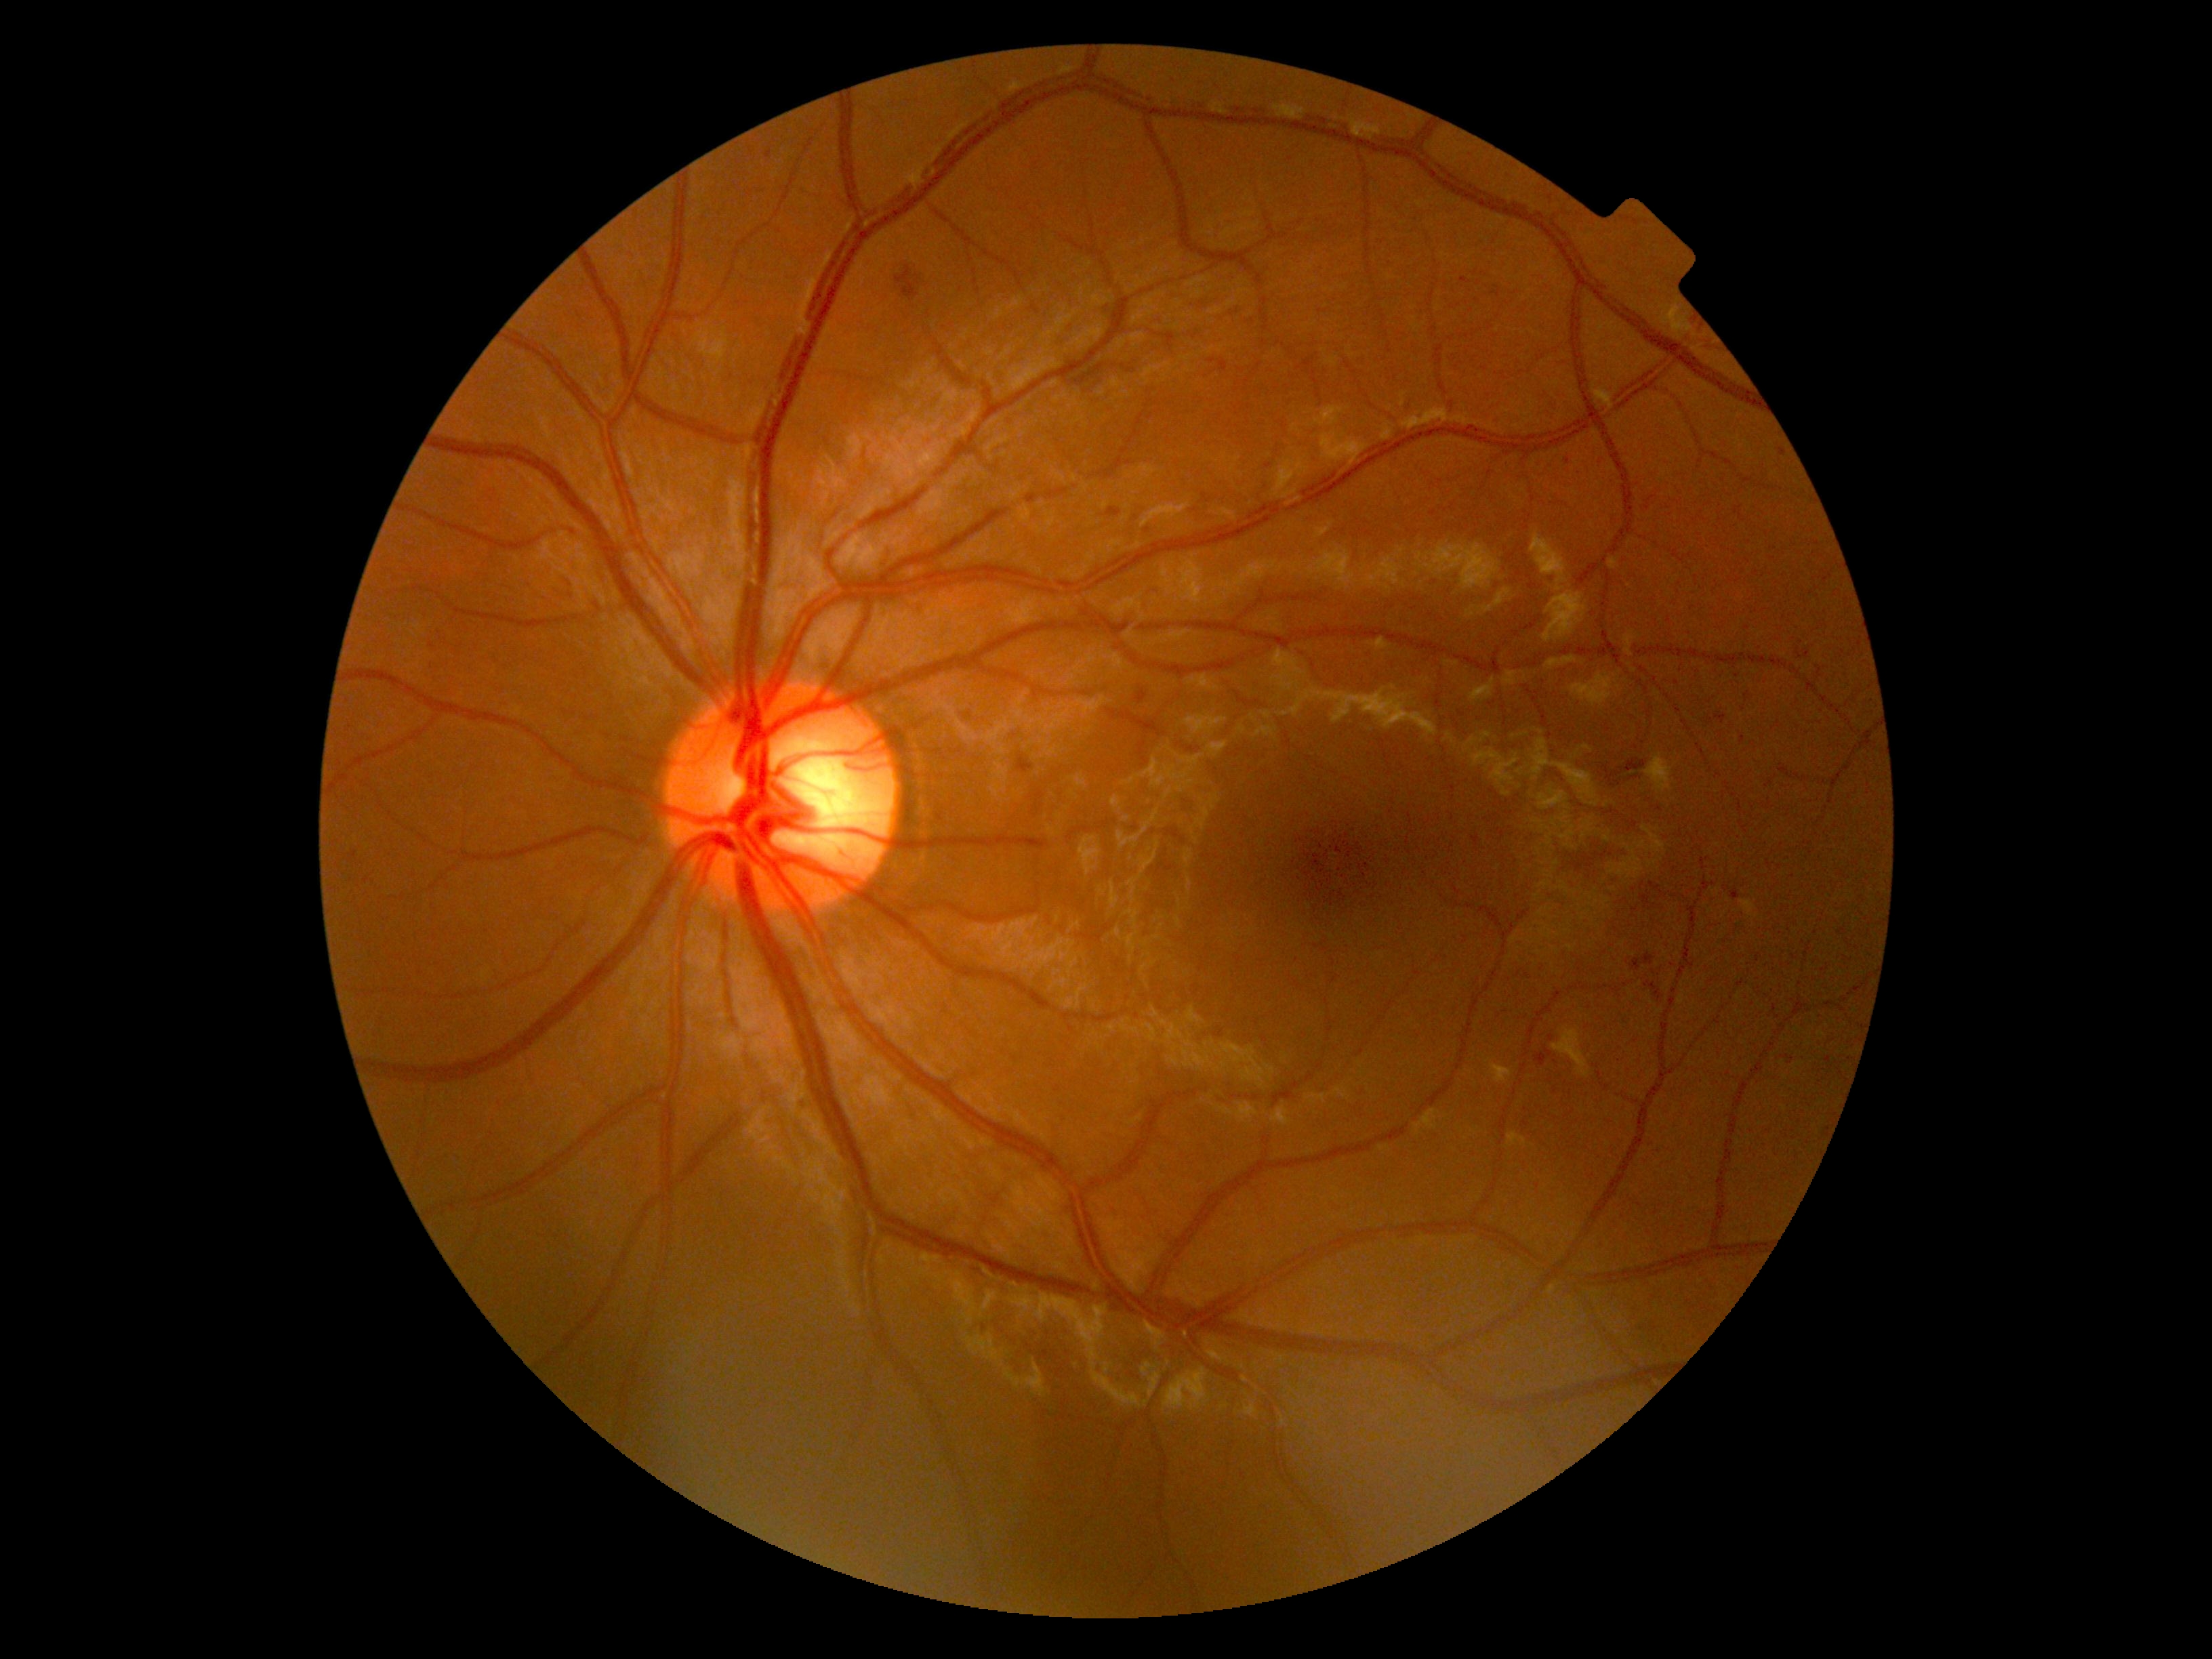

{
  "dr_grade": "moderate non-proliferative diabetic retinopathy (grade 2)"
}